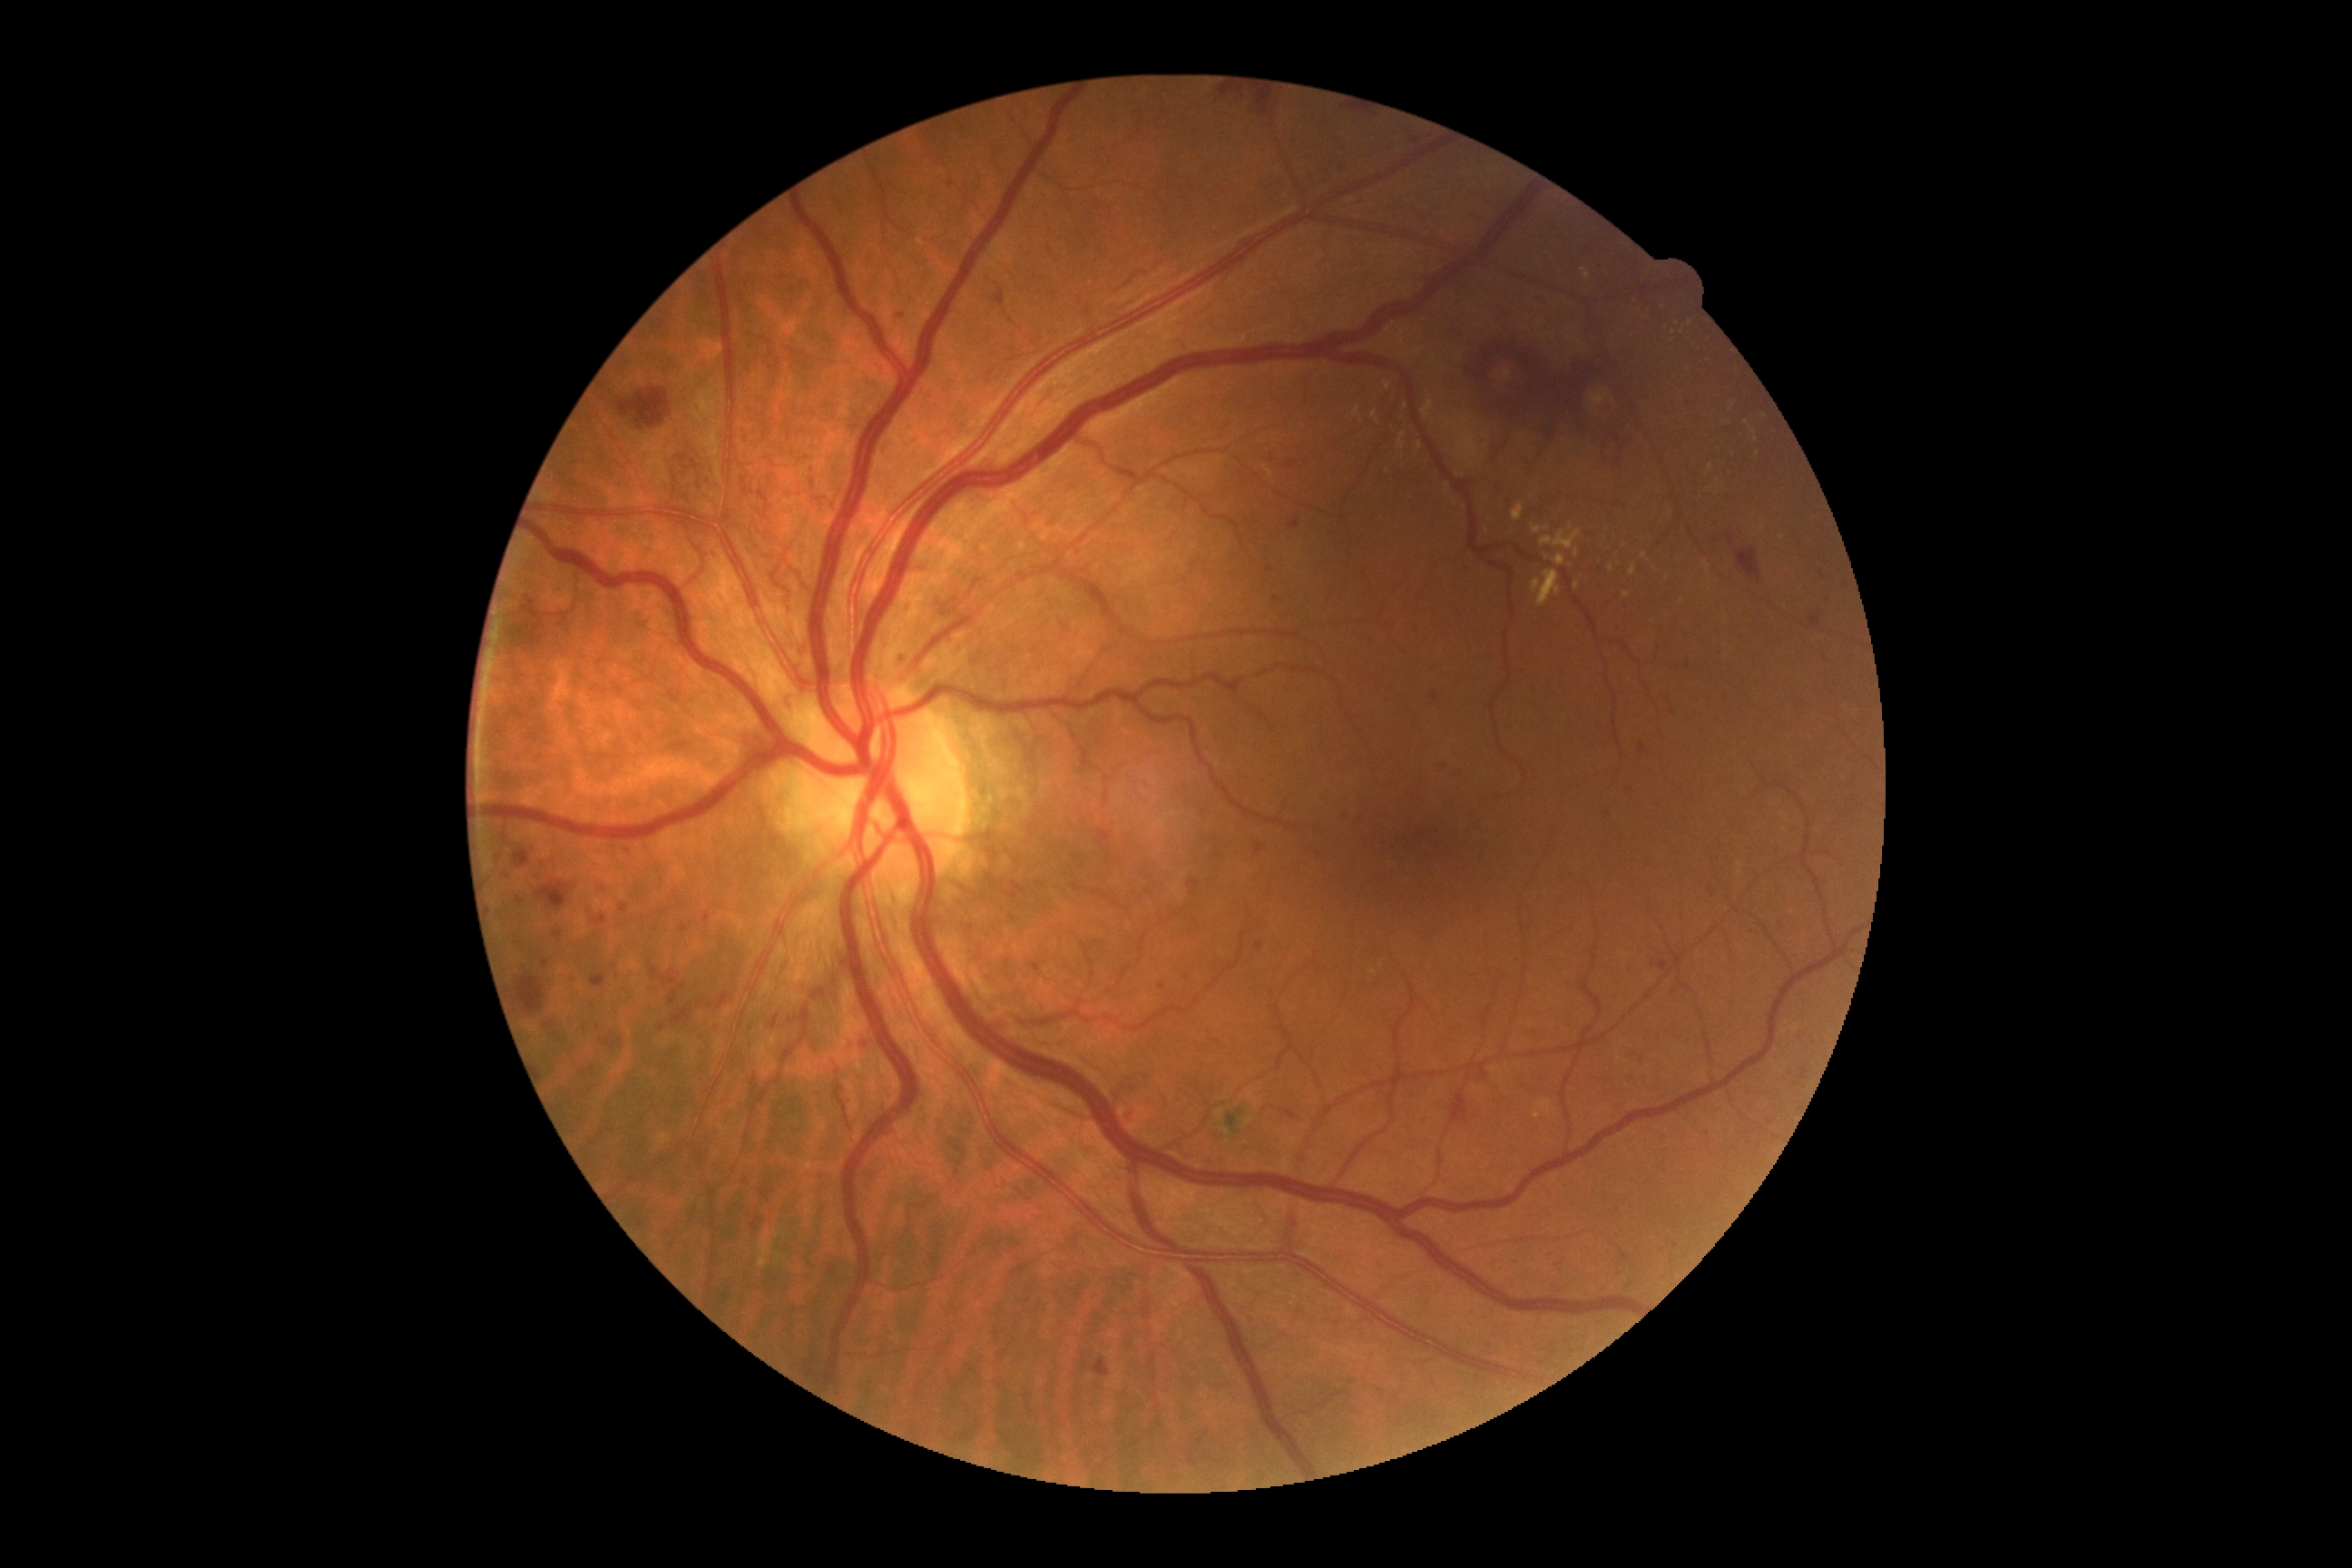

Diabetic retinopathy (DR): grade 3 (severe NPDR)
A subset of detected lesions:
microaneurysms (MAs) (continued): box(534, 874, 542, 883); box(593, 914, 607, 925); box(669, 985, 687, 1004); box(1032, 963, 1043, 972); box(1801, 1068, 1807, 1079); box(1289, 518, 1300, 529); box(1344, 812, 1348, 821); box(600, 1039, 611, 1046); box(1266, 565, 1275, 573); box(1602, 808, 1609, 816)
Additional small MAs near <point>1273, 460</point>; <point>592, 1068</point>; <point>1732, 542</point>; <point>1162, 987</point>; <point>1687, 666</point>; <point>813, 472</point>; <point>619, 981</point>; <point>1796, 1084</point>
hemorrhages (HEs) (continued): box(1188, 881, 1200, 896); box(620, 387, 671, 429); box(538, 881, 571, 910); box(513, 596, 547, 649); box(1099, 830, 1113, 845); box(518, 977, 545, 1014); box(651, 966, 680, 986); box(1467, 337, 1625, 438); box(591, 974, 607, 988); box(1736, 547, 1761, 582); box(1255, 843, 1264, 856); box(513, 850, 531, 868); box(1093, 1358, 1110, 1377); box(1603, 431, 1636, 471); box(1491, 424, 1516, 460); box(1259, 95, 1280, 117); box(1215, 90, 1240, 99); box(1449, 1095, 1469, 1126); box(709, 994, 732, 1010); box(672, 1008, 689, 1024)
soft exudates (SEs): none detected
hard exudates (EXs) (continued): box(1384, 382, 1391, 391); box(1446, 418, 1478, 467); box(1623, 593, 1631, 598); box(1416, 444, 1424, 451); box(917, 239, 925, 248); box(1712, 480, 1721, 489); box(1536, 569, 1560, 607); box(1582, 268, 1591, 280); box(1513, 504, 1524, 522); box(1398, 433, 1406, 451); box(1554, 554, 1565, 565)
Additional small EXs near <point>1547, 529</point>; <point>1690, 324</point>; <point>1752, 430</point>; <point>1757, 454</point>; <point>1374, 415</point>; <point>1680, 602</point>; <point>1577, 585</point>